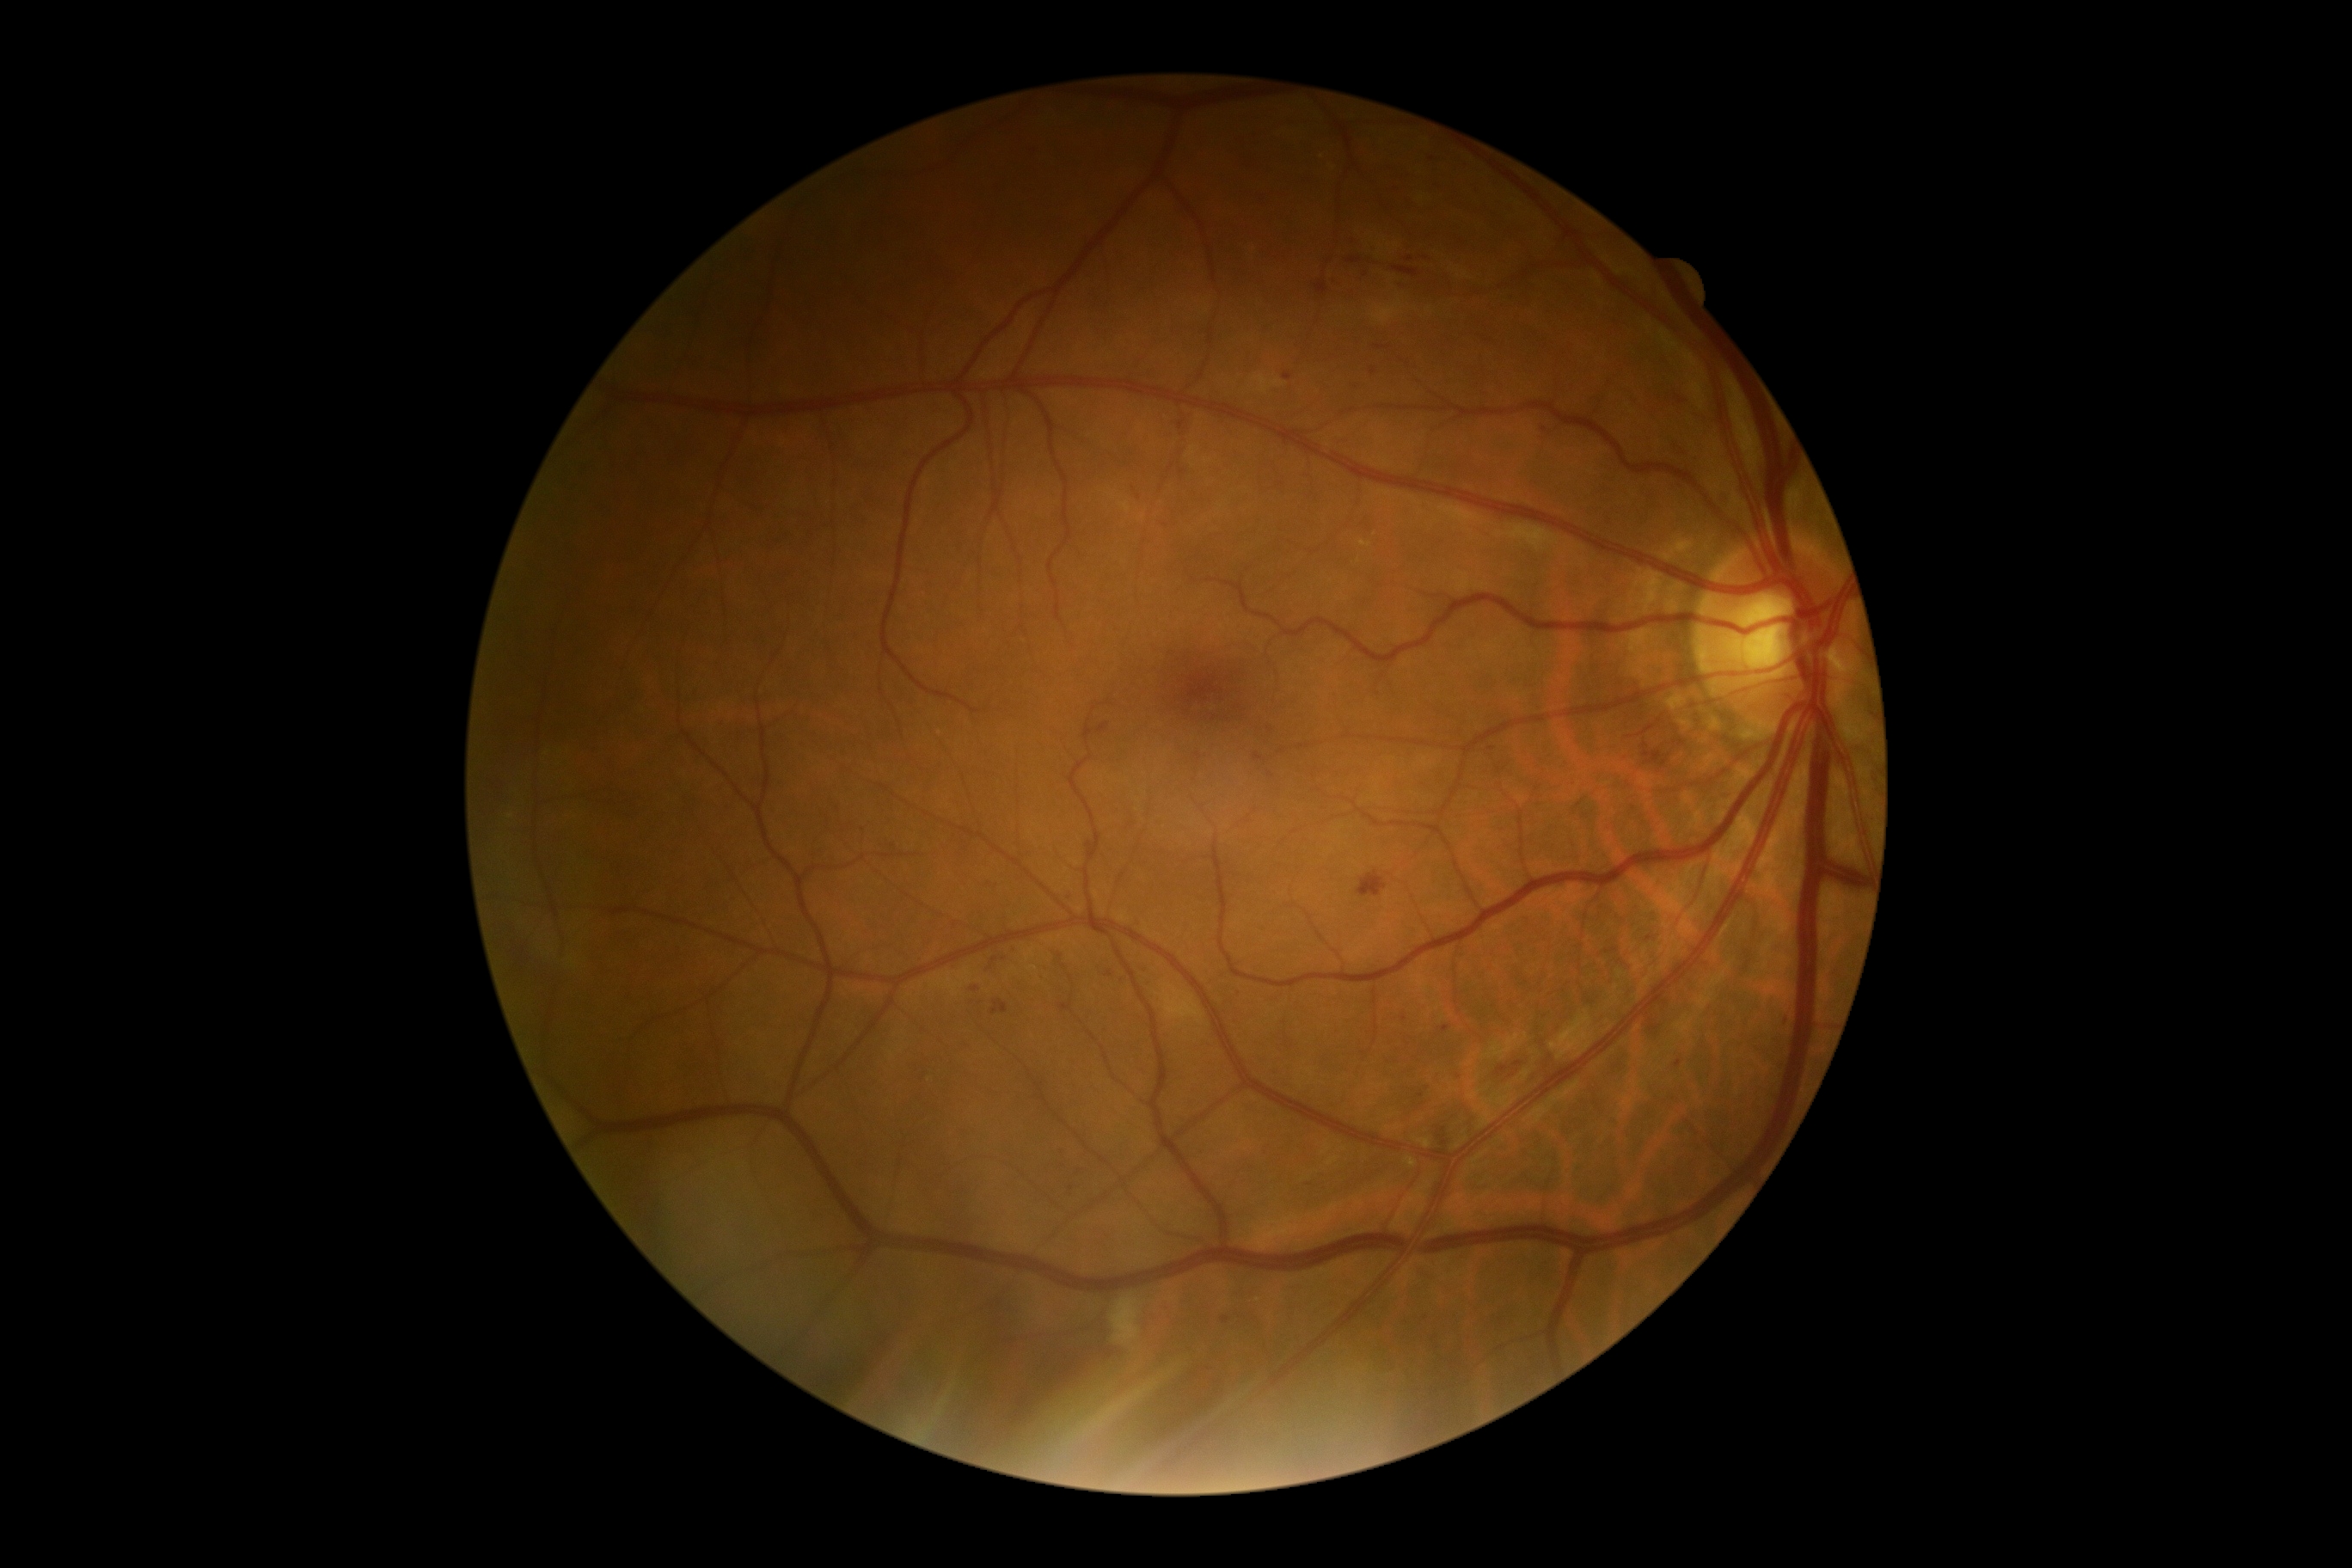

Diabetic retinopathy: grade 2 (moderate NPDR)
Representative lesions:
microaneurysms (subset): region(1399, 283, 1404, 291); region(1060, 1005, 1072, 1014); region(1136, 921, 1146, 933); region(1442, 1027, 1450, 1032); region(1675, 1060, 1682, 1069); region(1254, 754, 1265, 761); region(1222, 1316, 1230, 1325)
Microaneurysms (small, approximate centers) near (988, 967); (1783, 1020); (995, 961); (1060, 1154); (1650, 939); (1405, 1019); (1109, 974)